Wide-field fundus image from infant ROP screening.
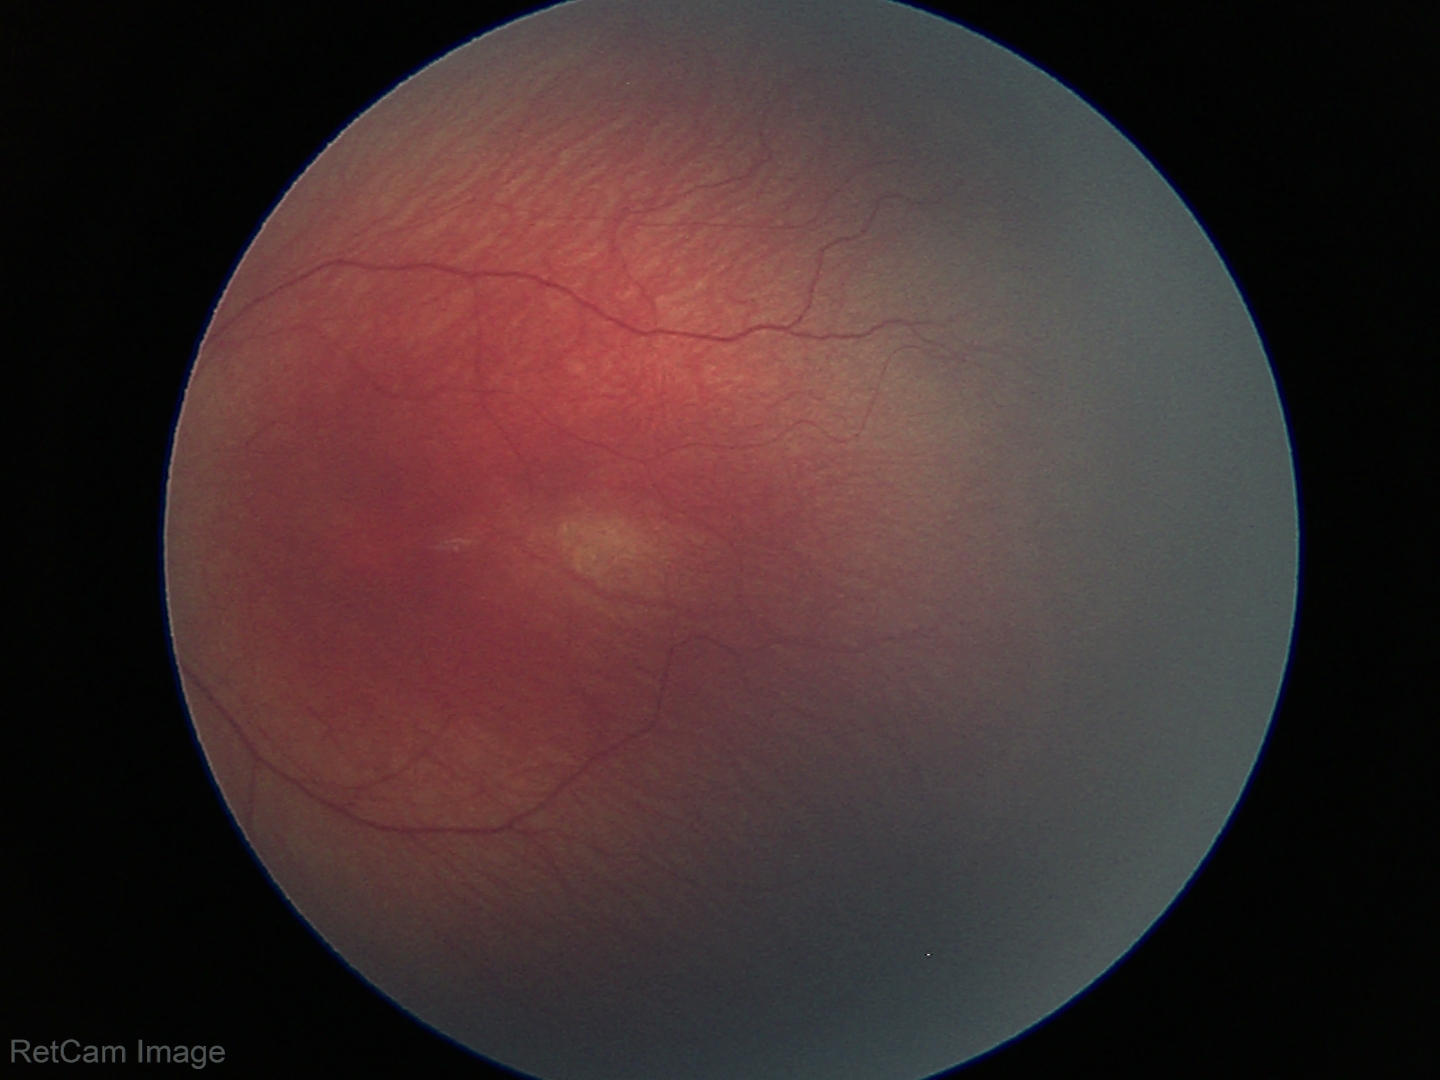
Without plus disease. Screening examination consistent with retinopathy of prematurity stage 1.